45° field of view · fundus photo
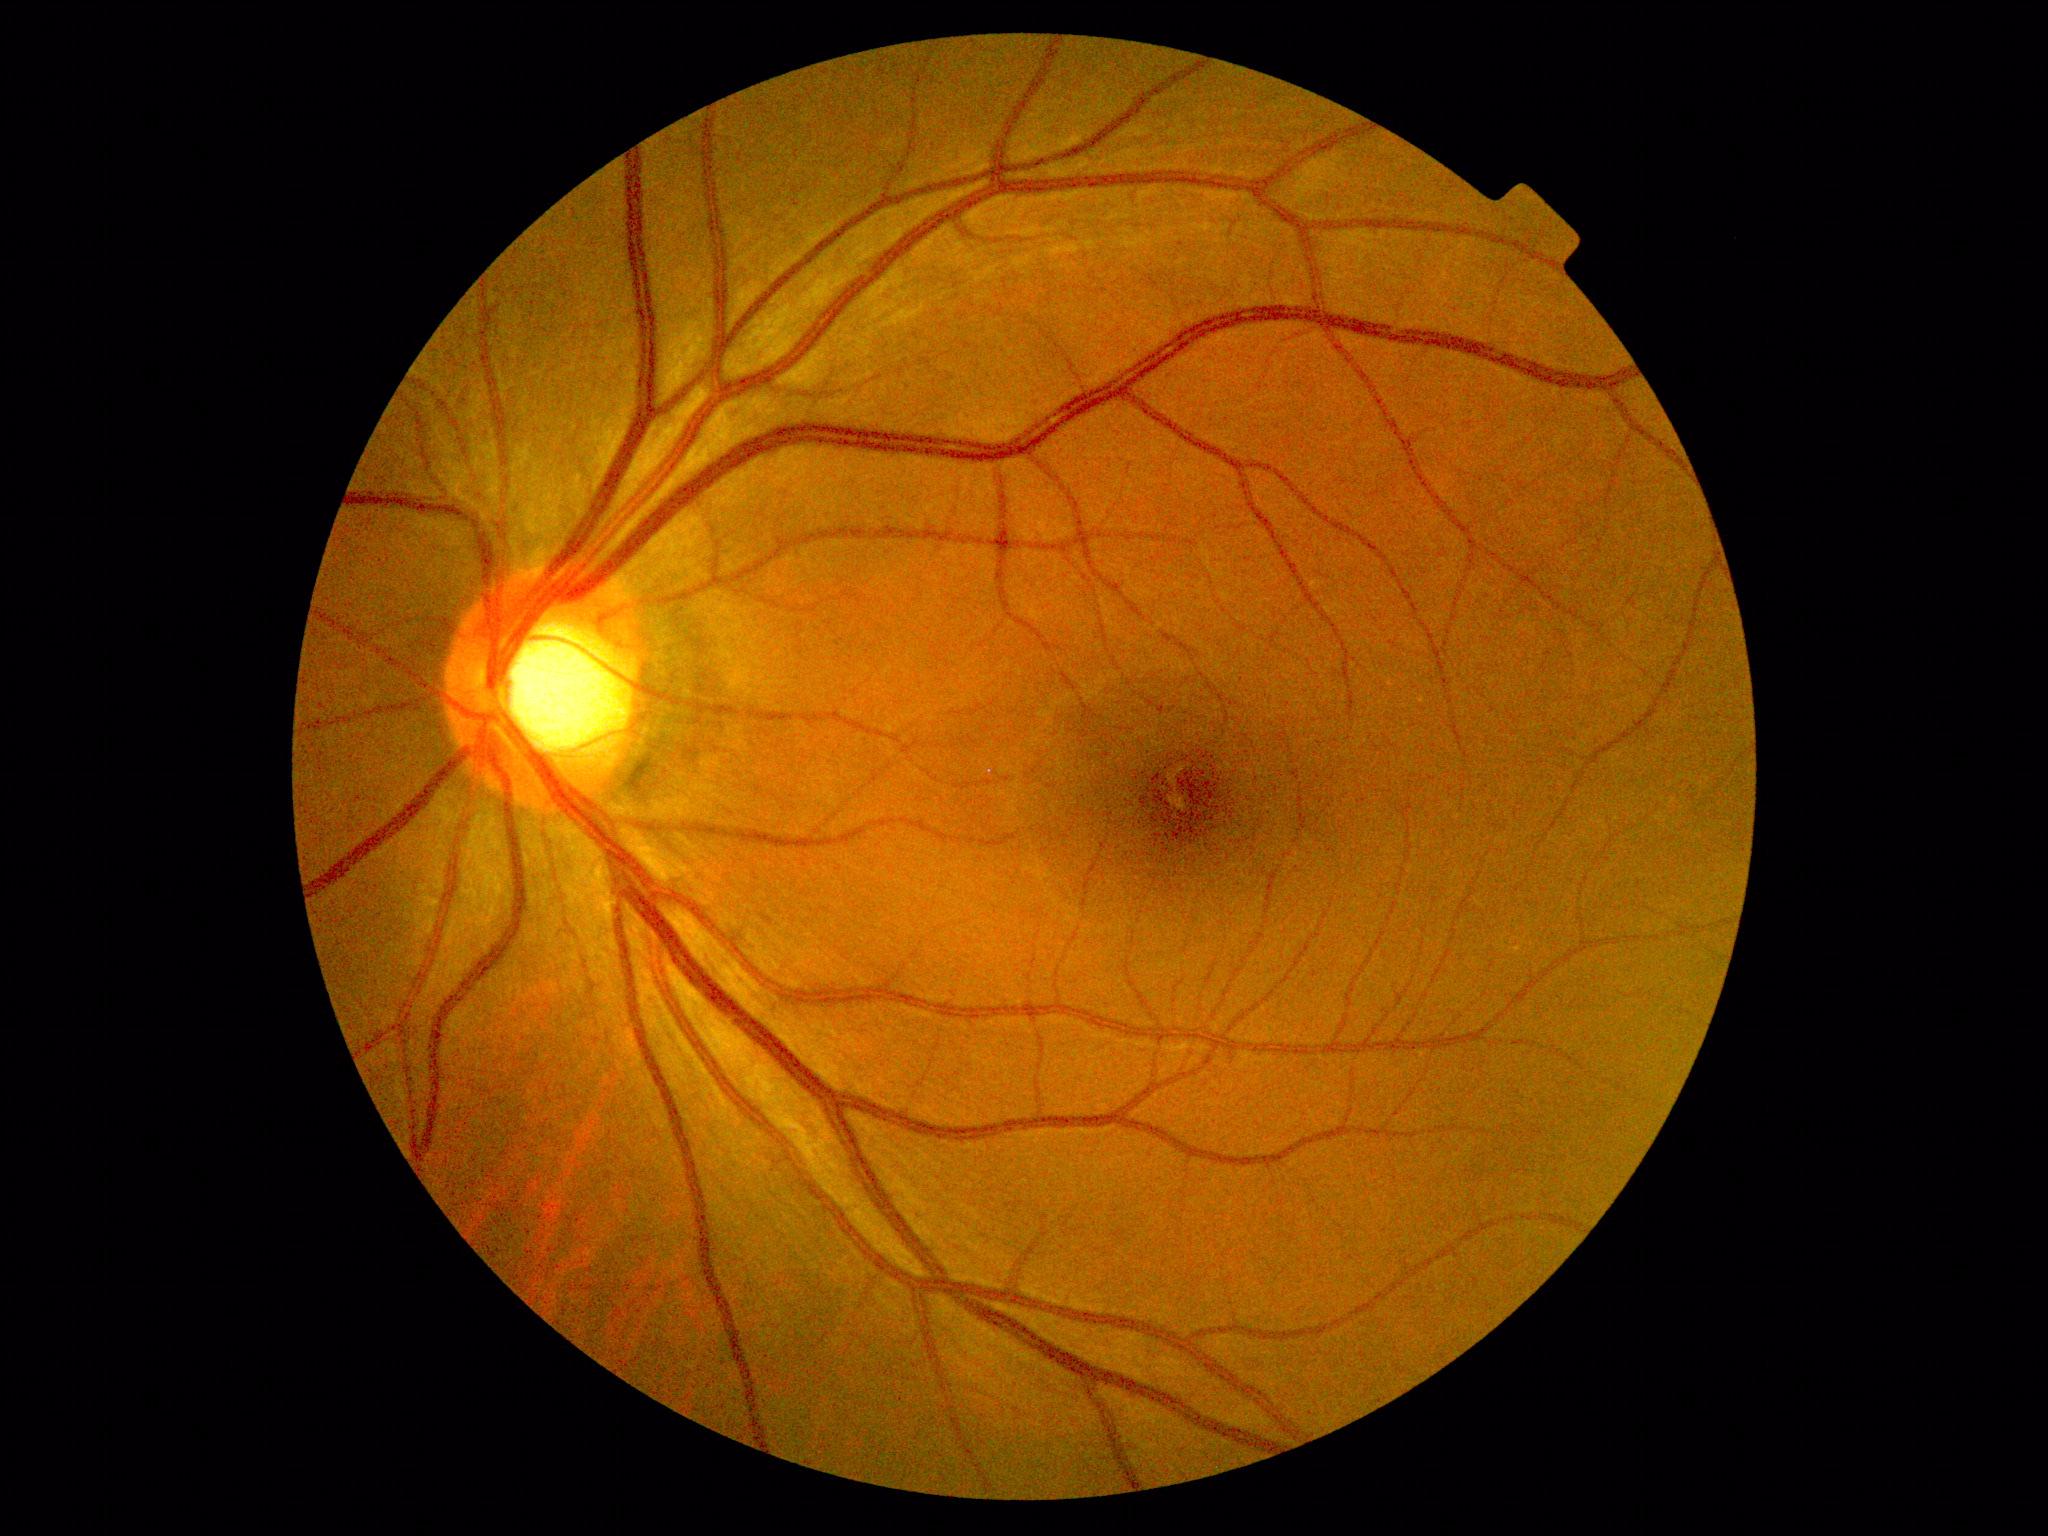
  dr_grade: 0
  dr_impression: no apparent DR